Intraocular pressure (IOP) 19 mmHg; patient age: 58 years; visual field mean deviation: -3.26 dB; refractive error: sphere +1.5 D, cylinder -1.75 D, axis 85°; woman:
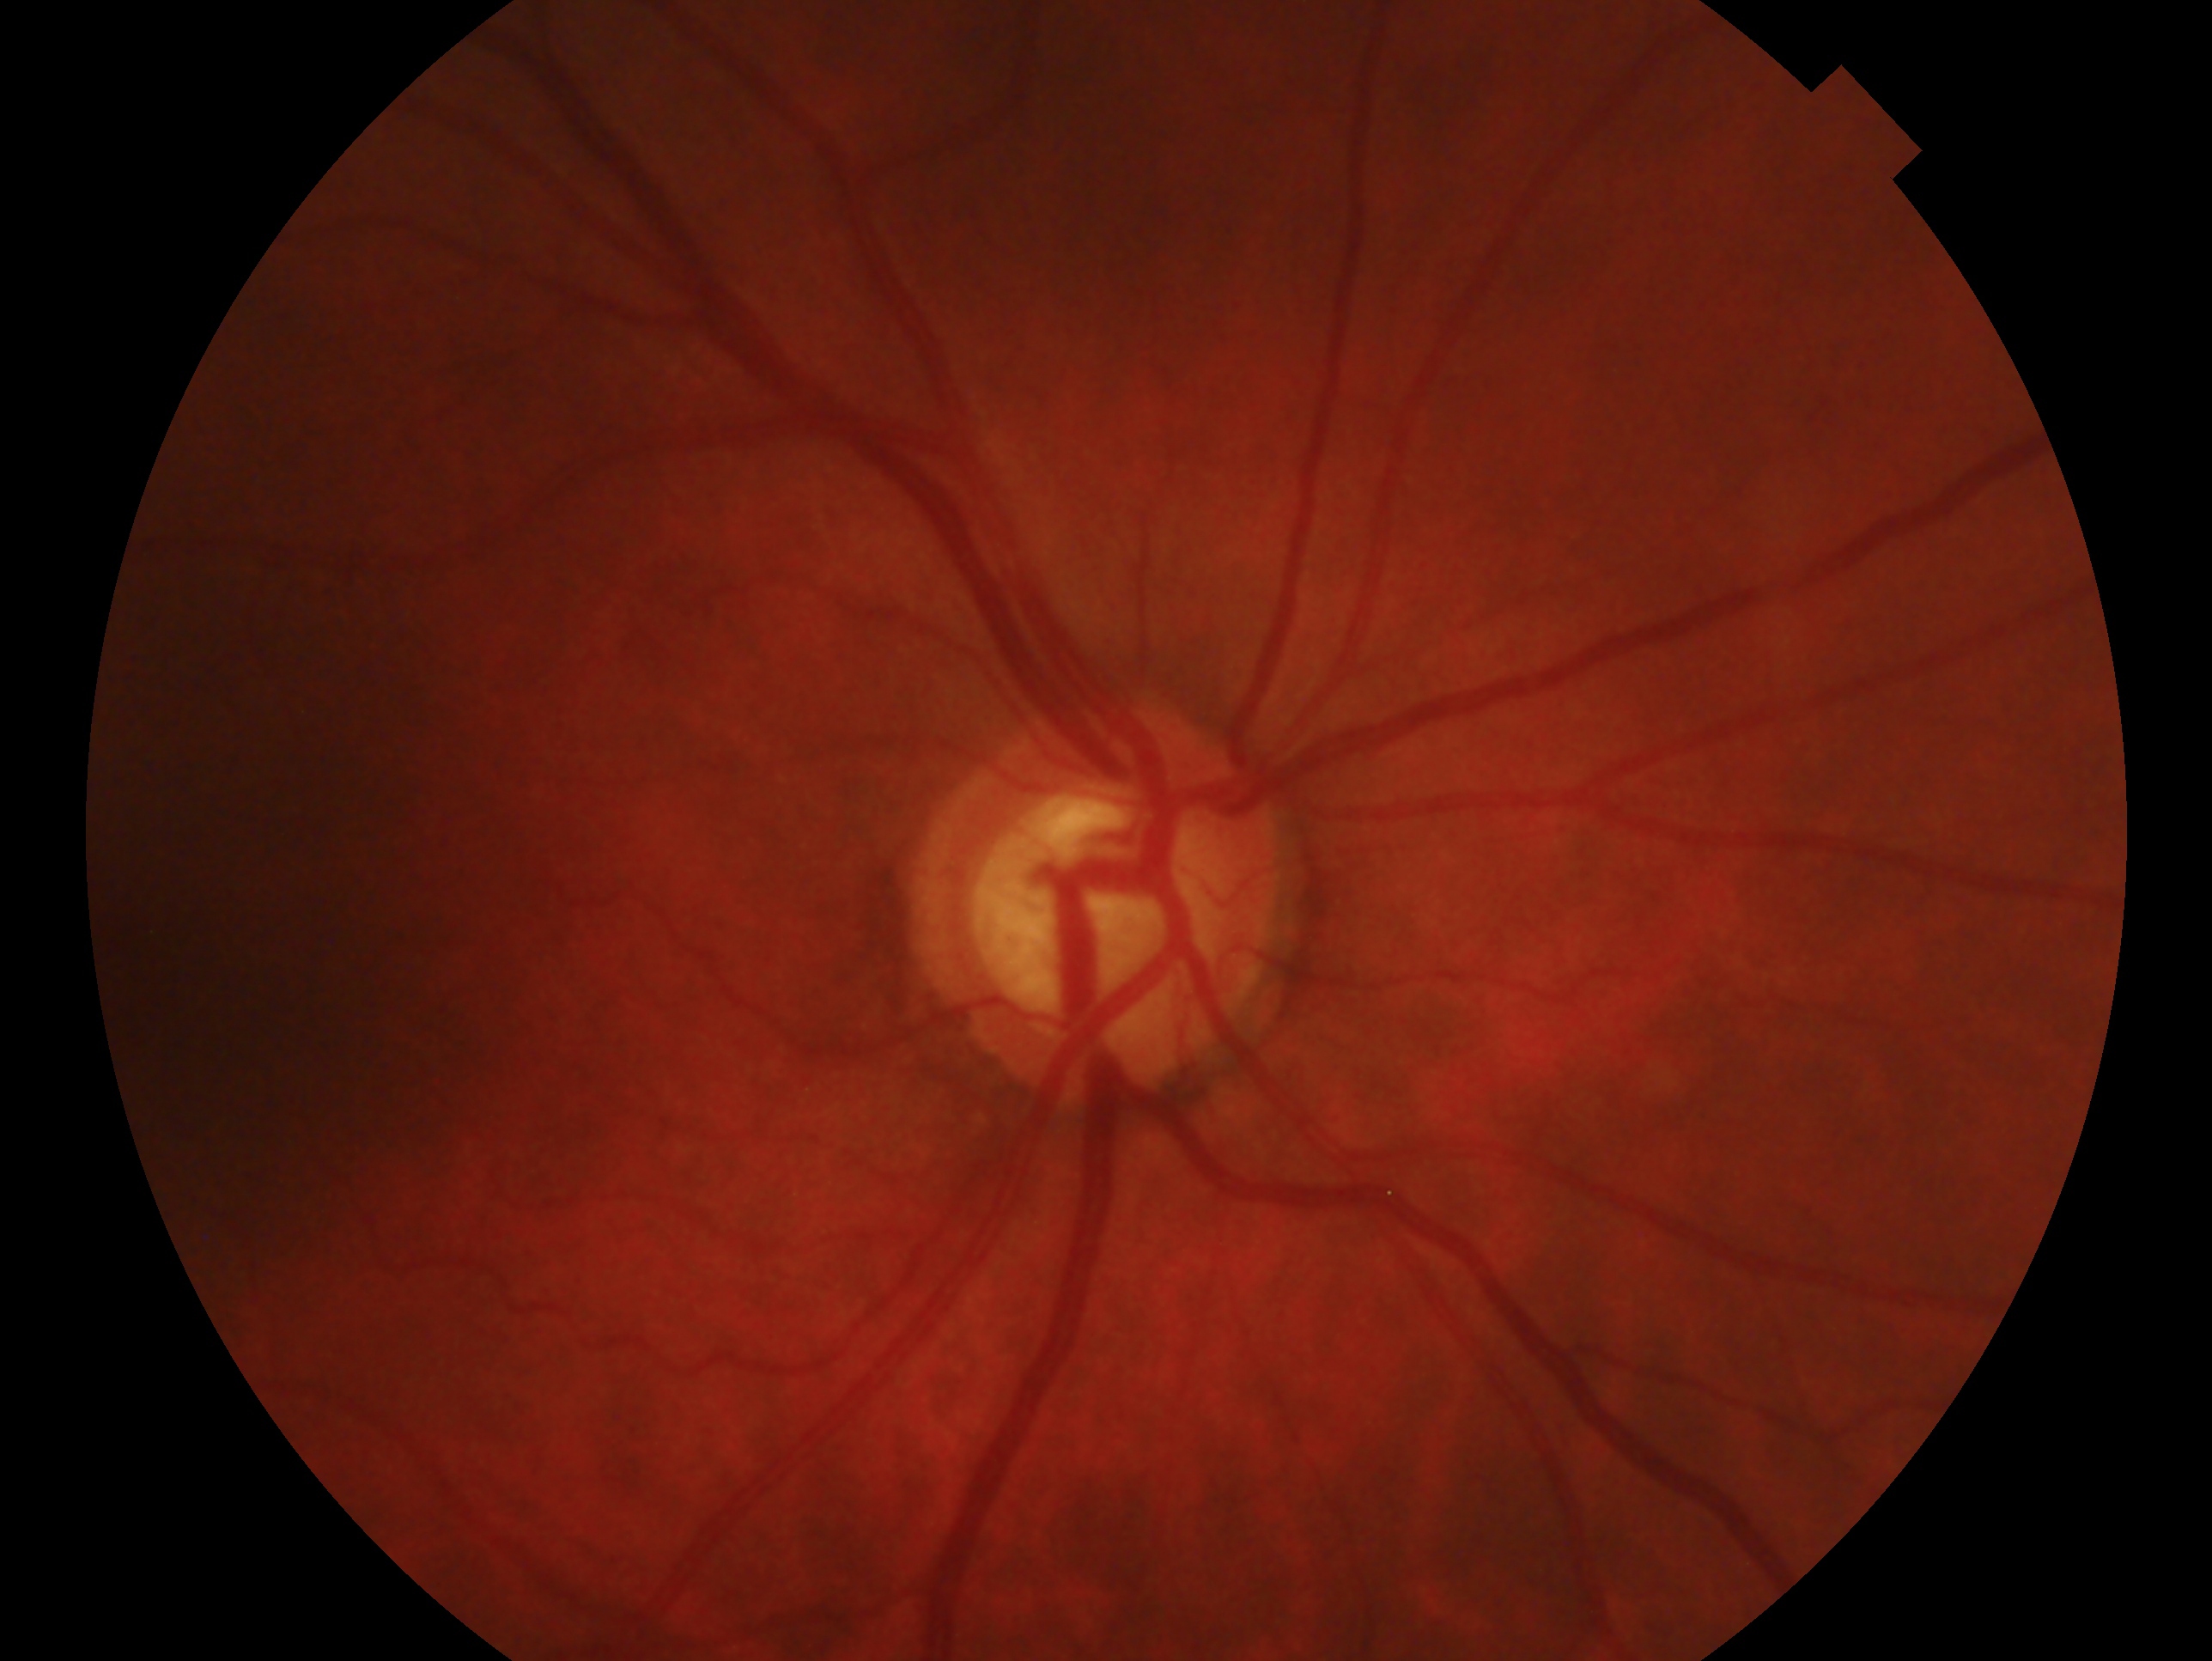 clinical classification: consistent with glaucoma | laterality: right eye.